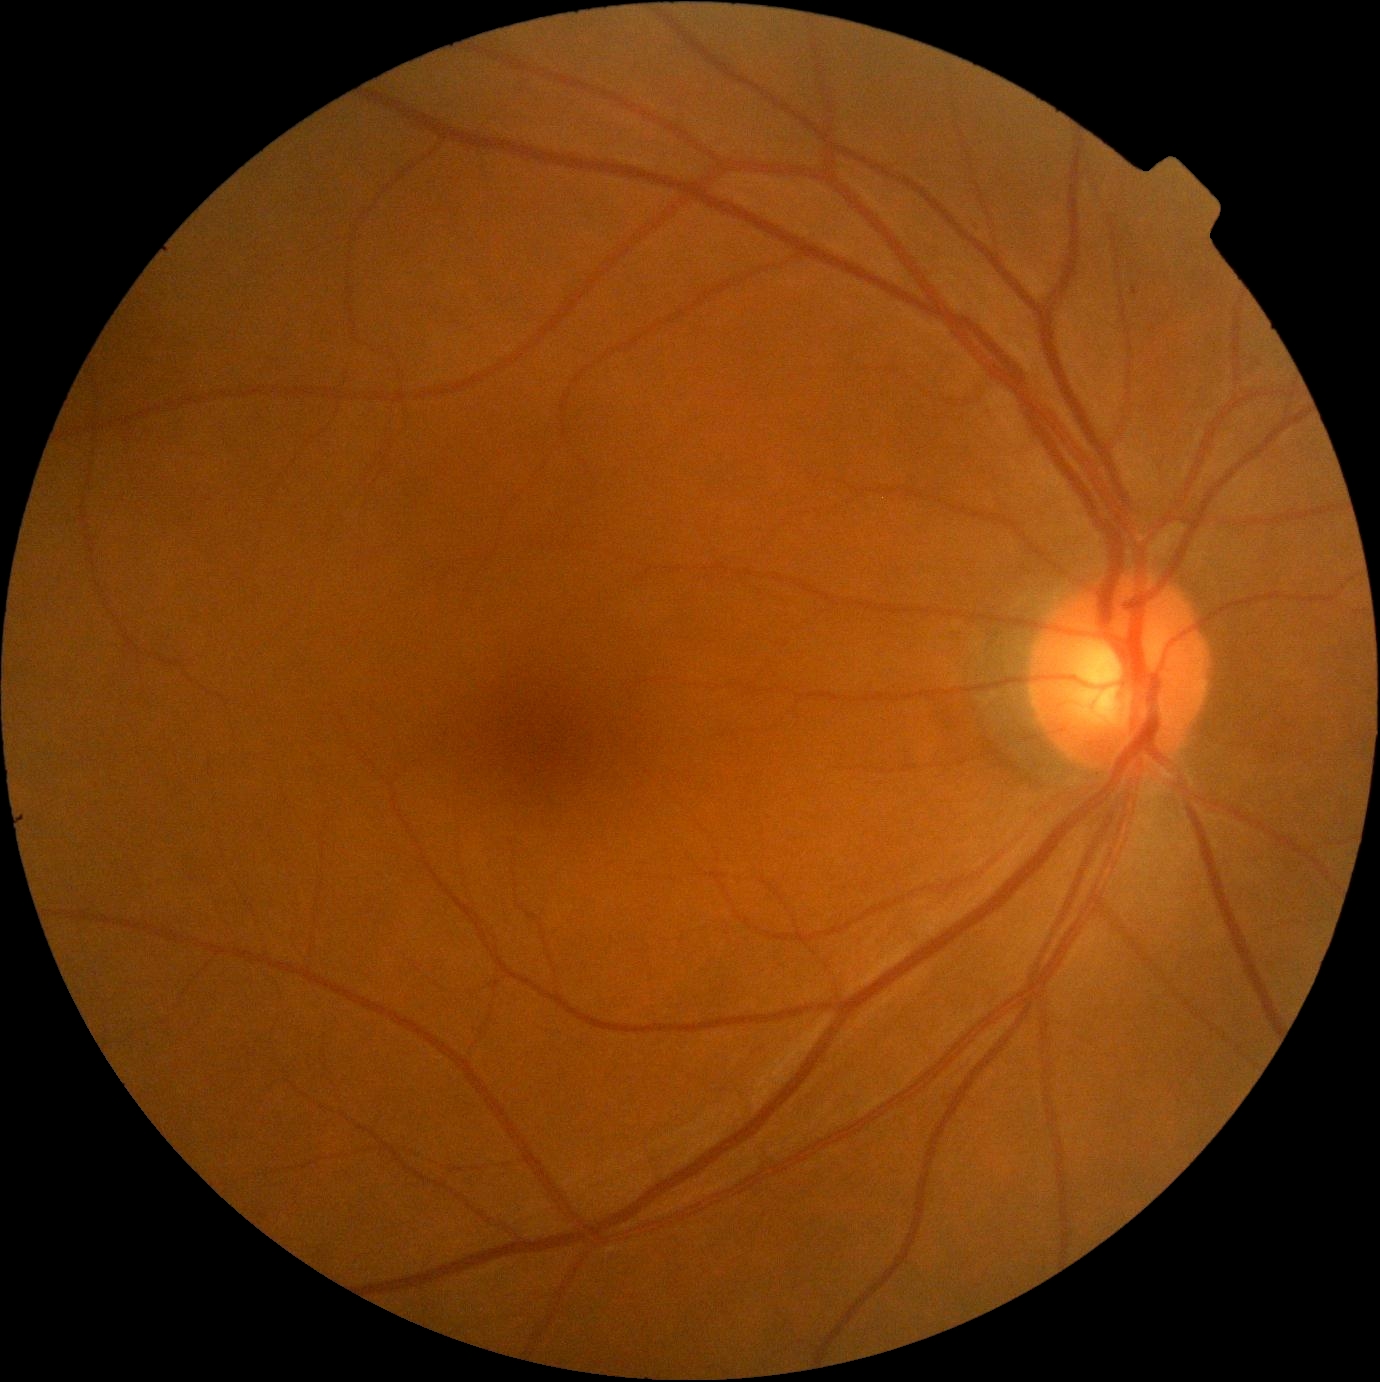
Diabetic retinopathy (DR) is 0.